NIDEK AFC-230. 848 x 848 pixels. Posterior pole color fundus photograph — 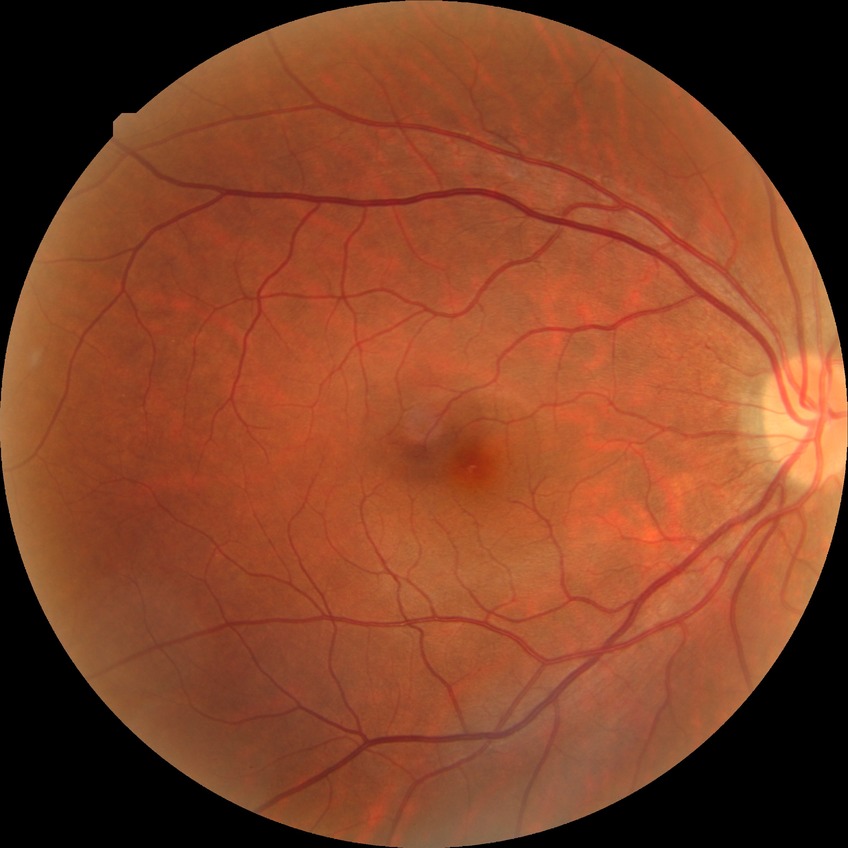
• diabetic retinopathy (DR): NDR (no diabetic retinopathy)